Pediatric wide-field fundus photograph:
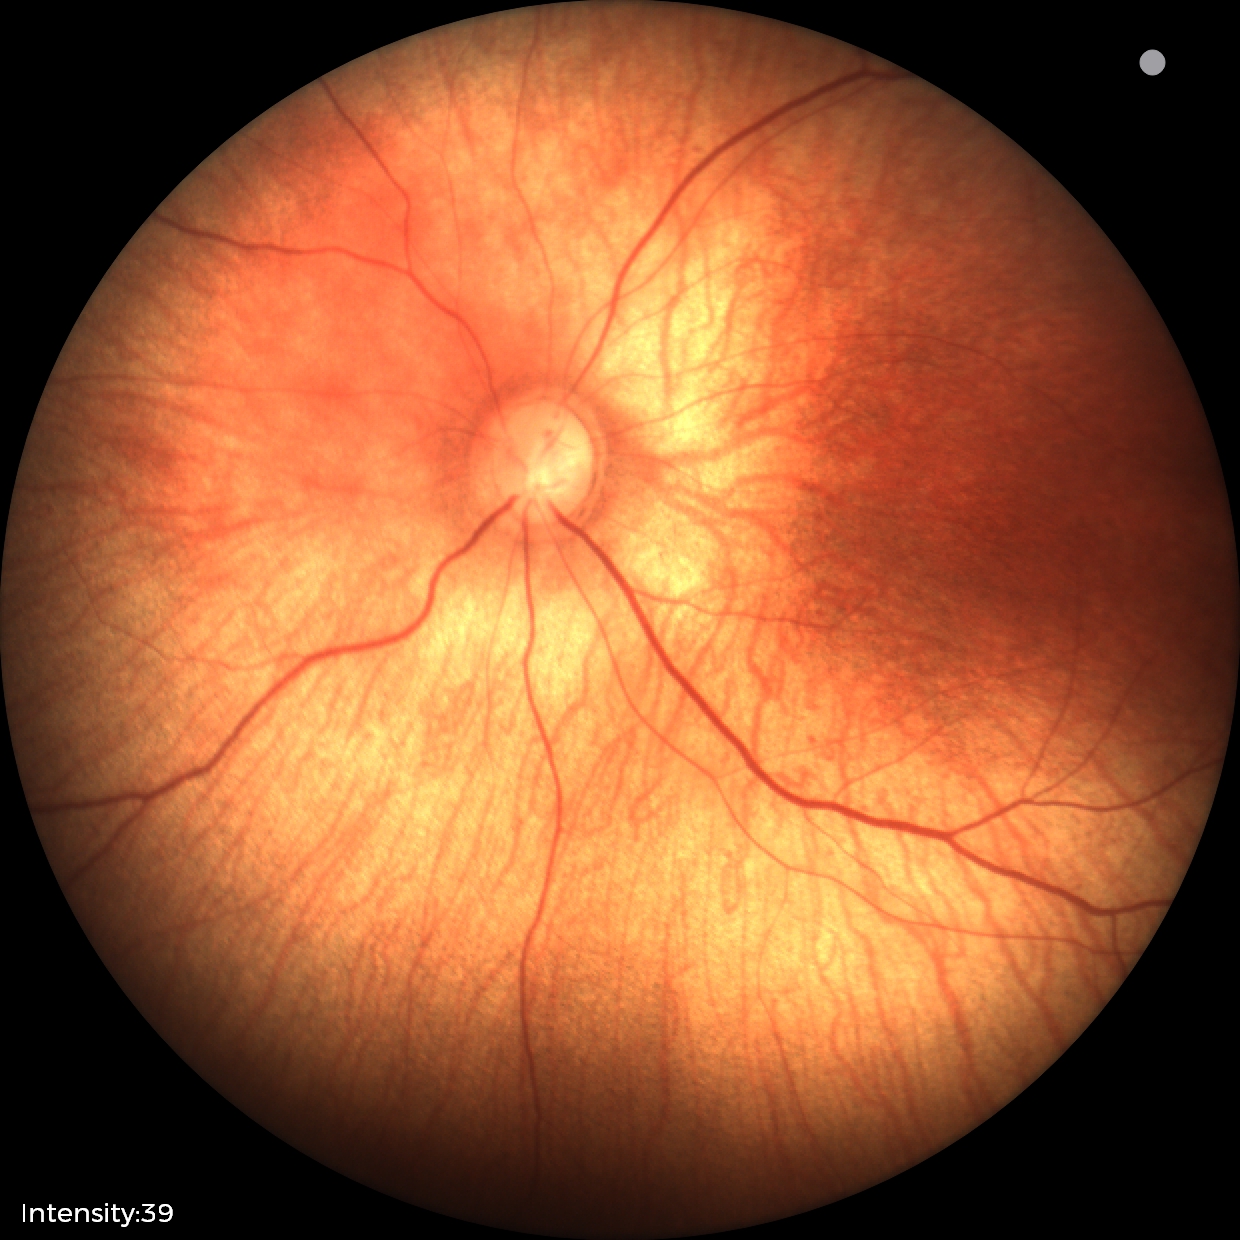 Assessment: physiological retinal finding.